Diabetic retinopathy graded by the modified Davis classification, without pupil dilation, 848 x 848 pixels
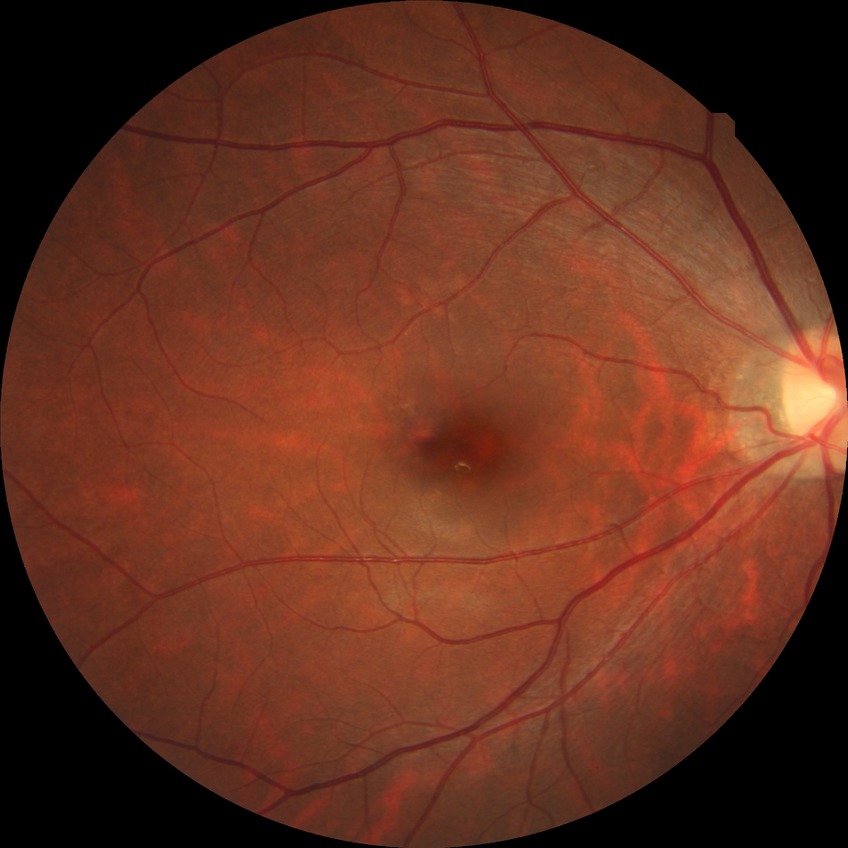
Diabetic retinopathy grade: no diabetic retinopathy.